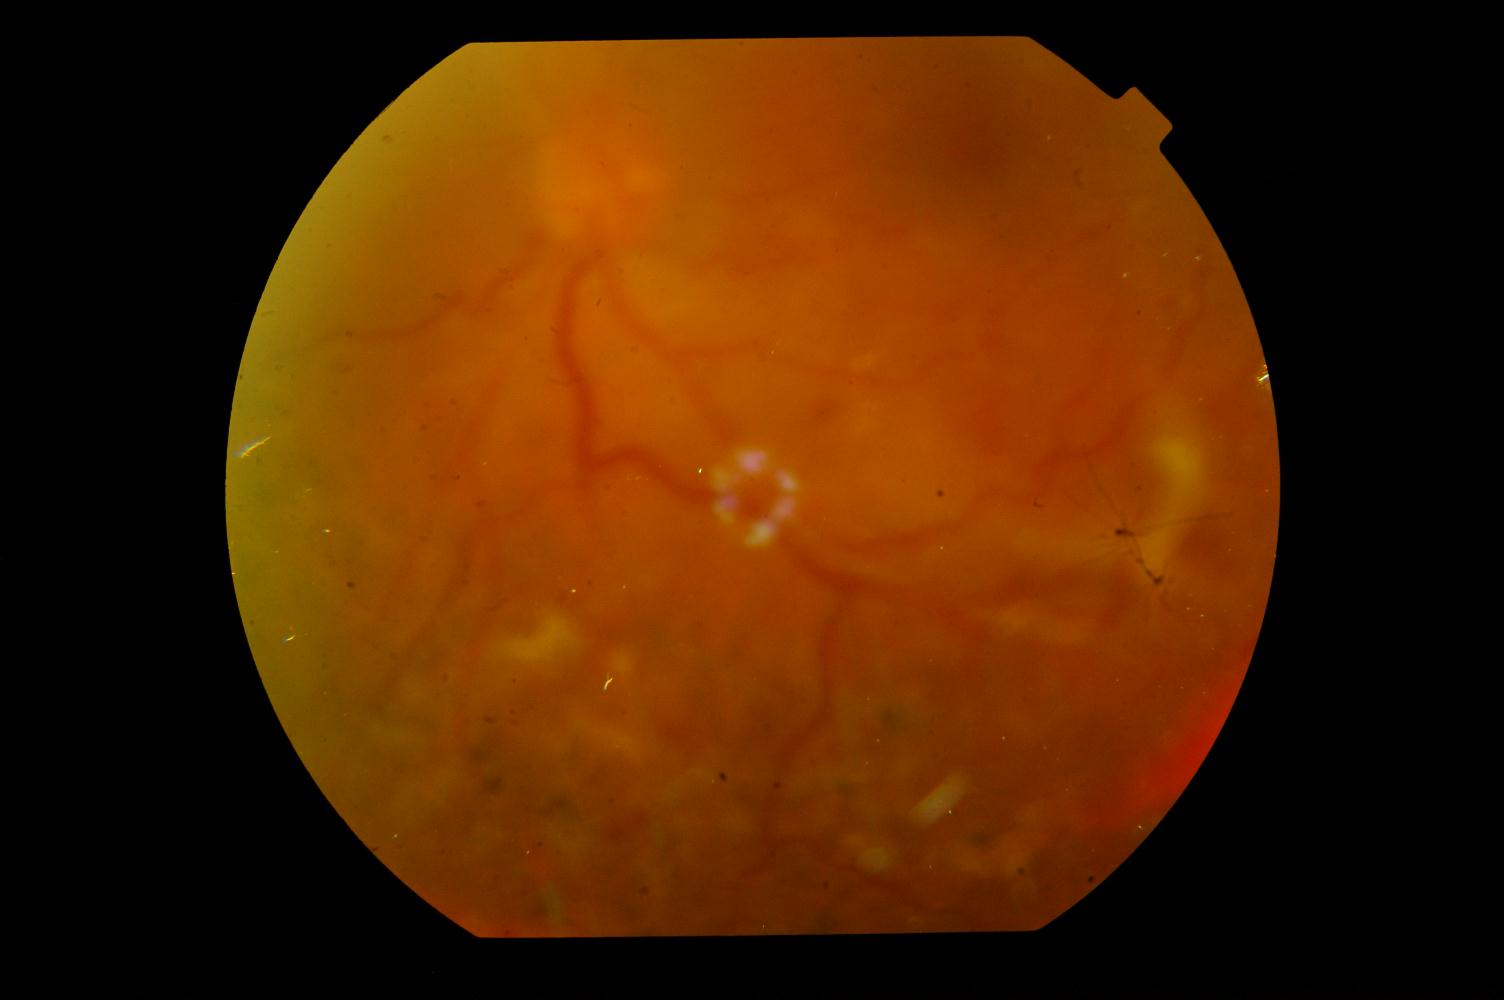

Findings consistent with diabetic retinopathy (DR).